640 x 480 pixels; wide-field fundus image from infant ROP screening — 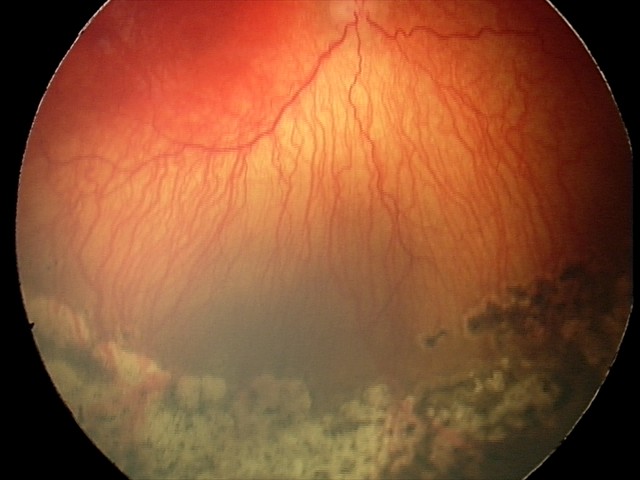 Screening series with aggressive retinopathy of prematurity. Plus disease was diagnosed.